Modified Davis grading; 45 degree fundus photograph; 848x848; CFP — 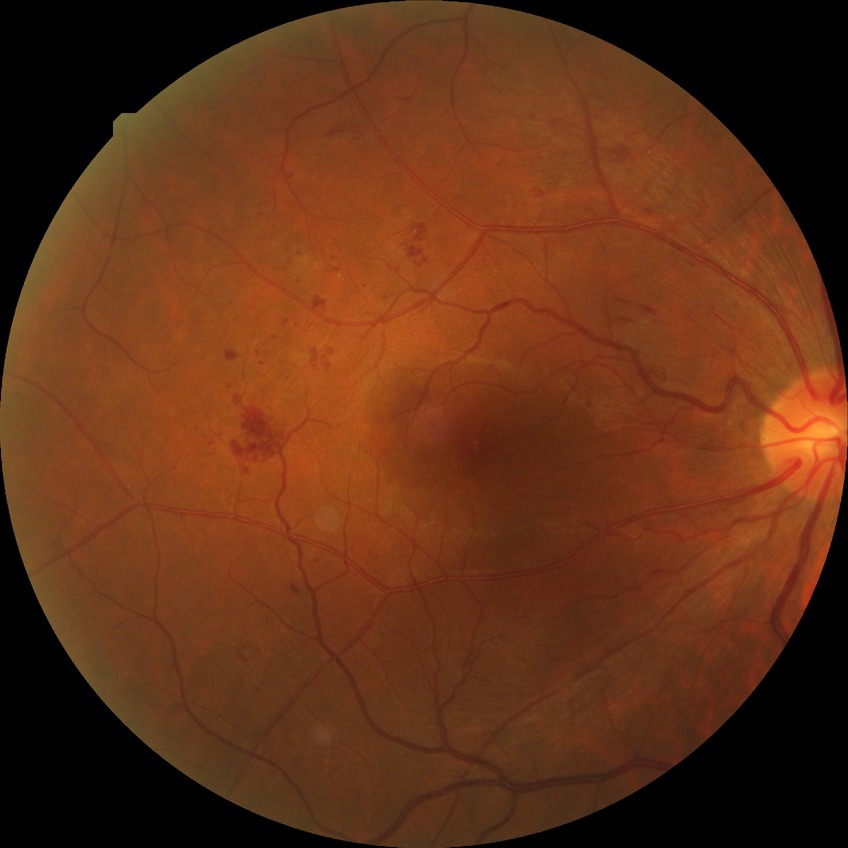

- DR class: non-proliferative diabetic retinopathy
- diabetic retinopathy (DR): PPDR (pre-proliferative diabetic retinopathy)